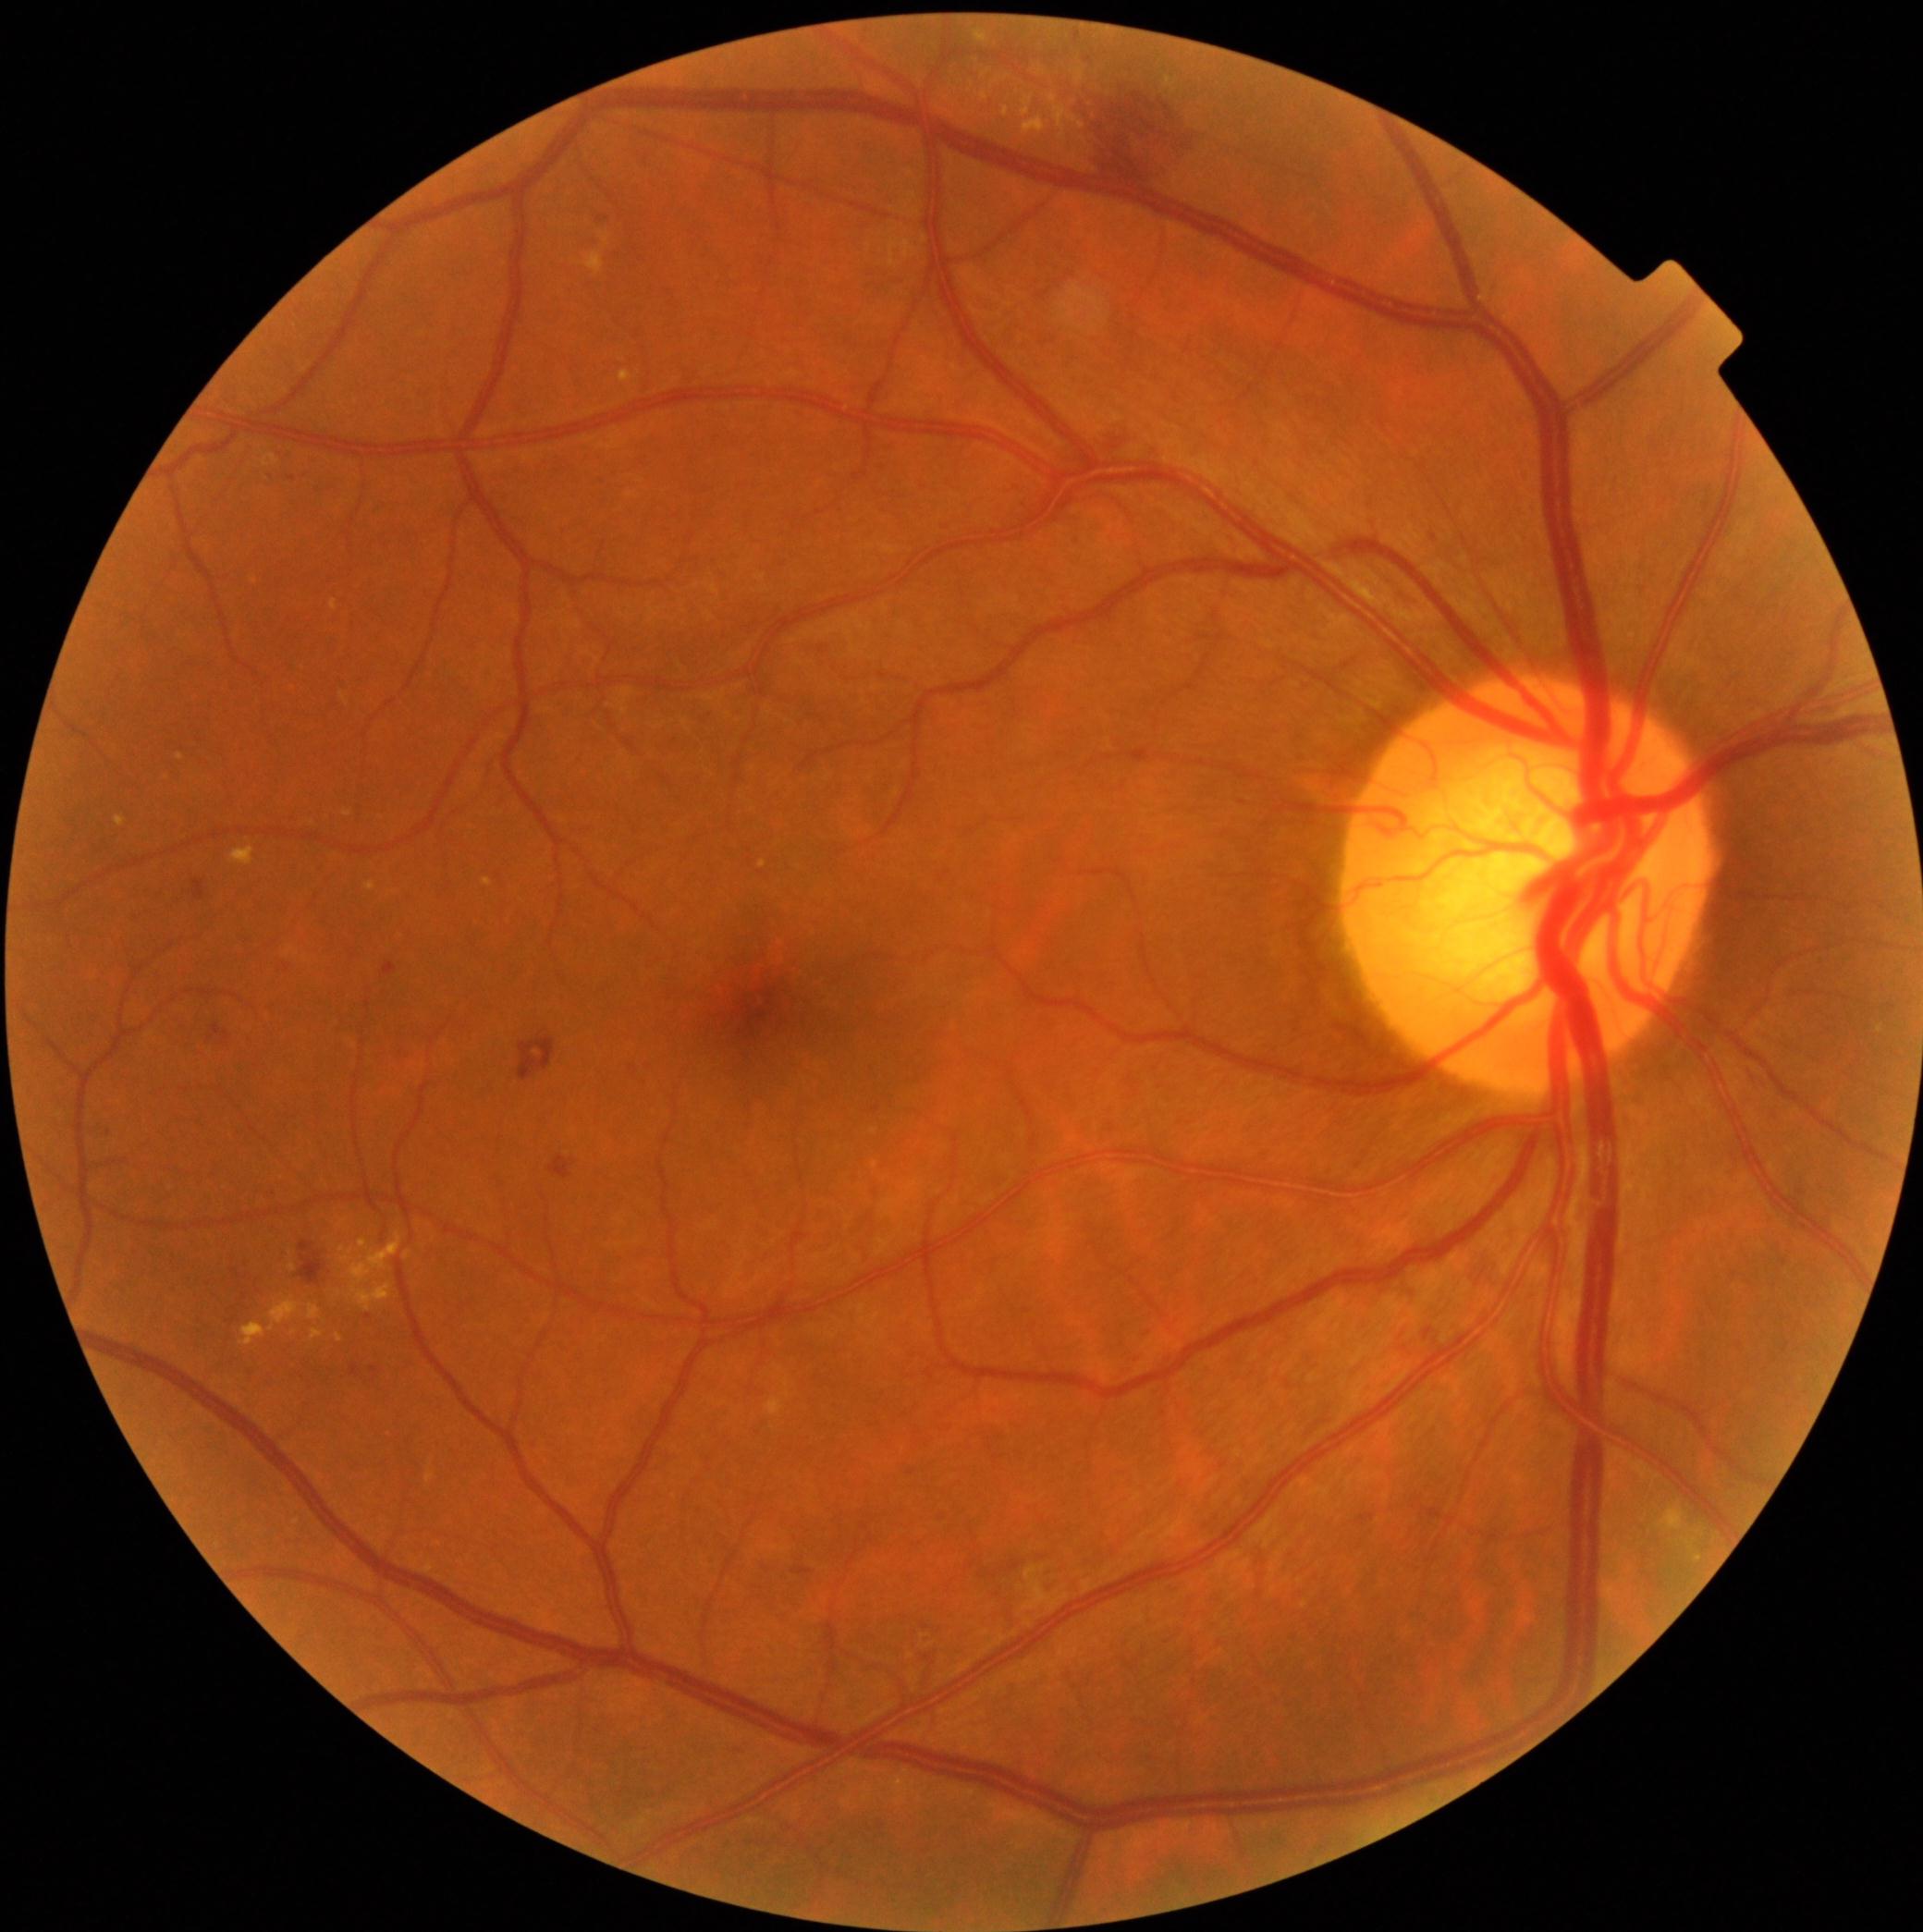 <lesions partial="true">
  <dr_grade>2</dr_grade>
  <ex partial="true">[x1=599, y1=233, x2=612, y2=246]; [x1=1023, y1=116, x2=1047, y2=136]; [x1=344, y1=811, x2=353, y2=818]; [x1=1048, y1=94, x2=1086, y2=140]; [x1=359, y1=1240, x2=368, y2=1251]; [x1=981, y1=92, x2=988, y2=100]; [x1=1656, y1=1508, x2=1684, y2=1534]; [x1=1694, y1=1554, x2=1703, y2=1564]; [x1=262, y1=454, x2=280, y2=468]; [x1=1004, y1=107, x2=1010, y2=117]; [x1=312, y1=1329, x2=324, y2=1340]</ex>
  <ex_small>1042/73; 294/1334</ex_small>
</lesions>